Wide-field fundus photograph from neonatal ROP screening:
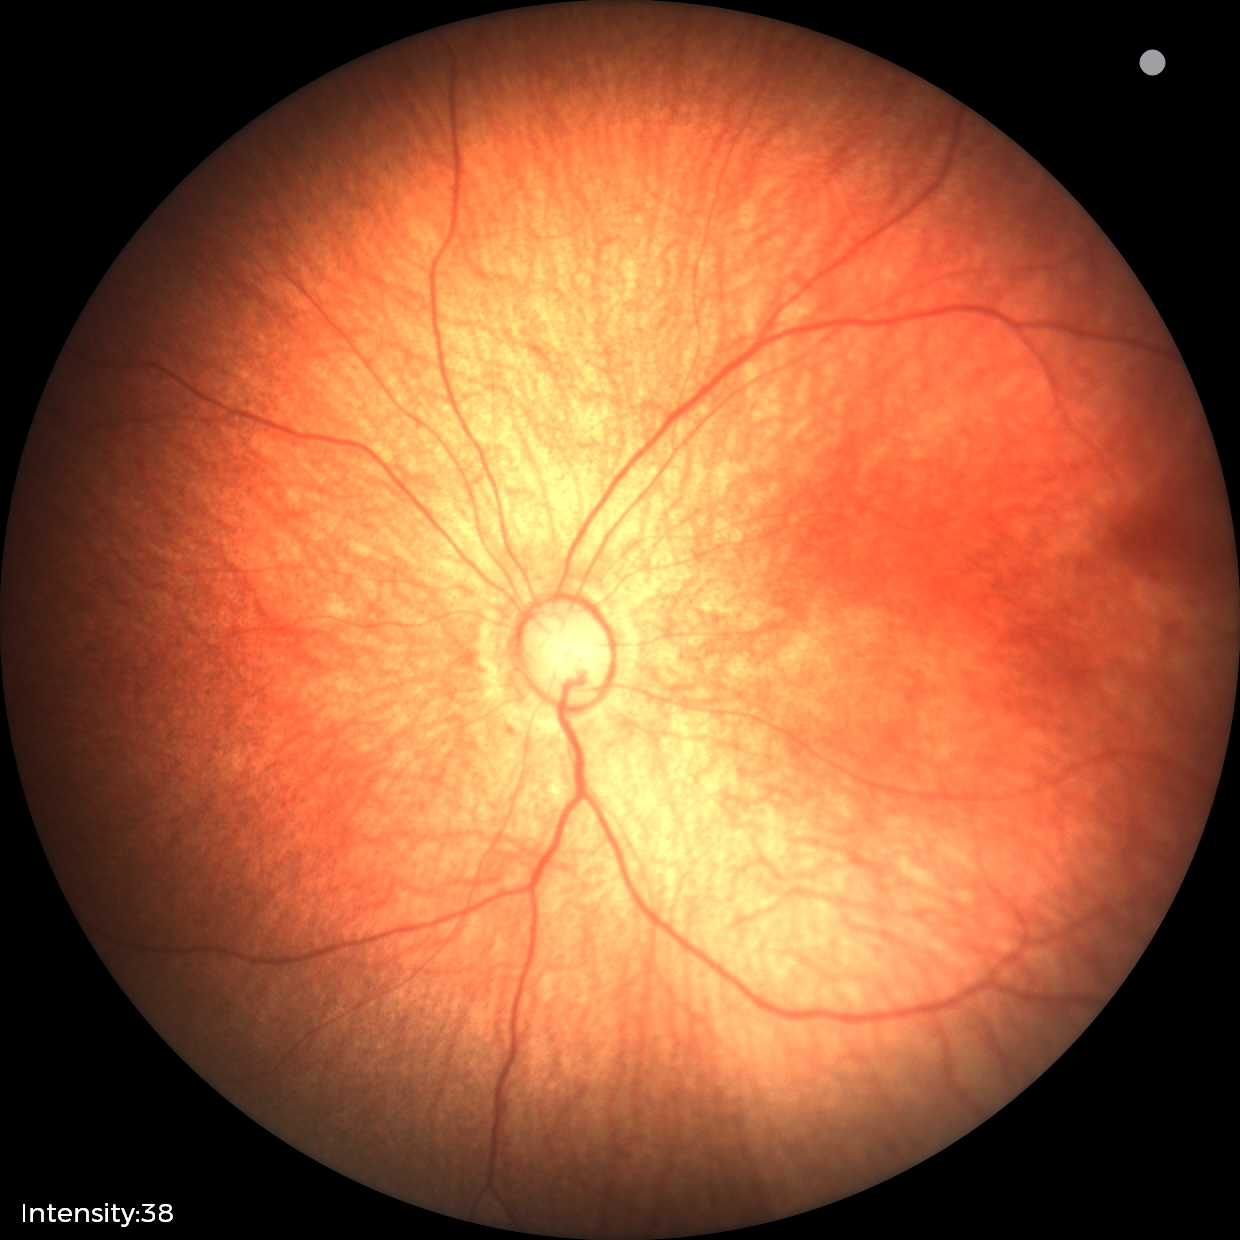

Examination with physiological retinal findings.